Nidek AFC-330.
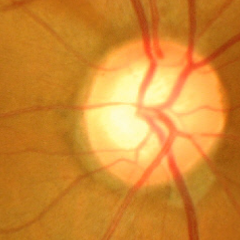

Glaucomatous changes are present. Color fundus photograph showing advanced glaucomatous optic neuropathy.